Modified Davis classification — 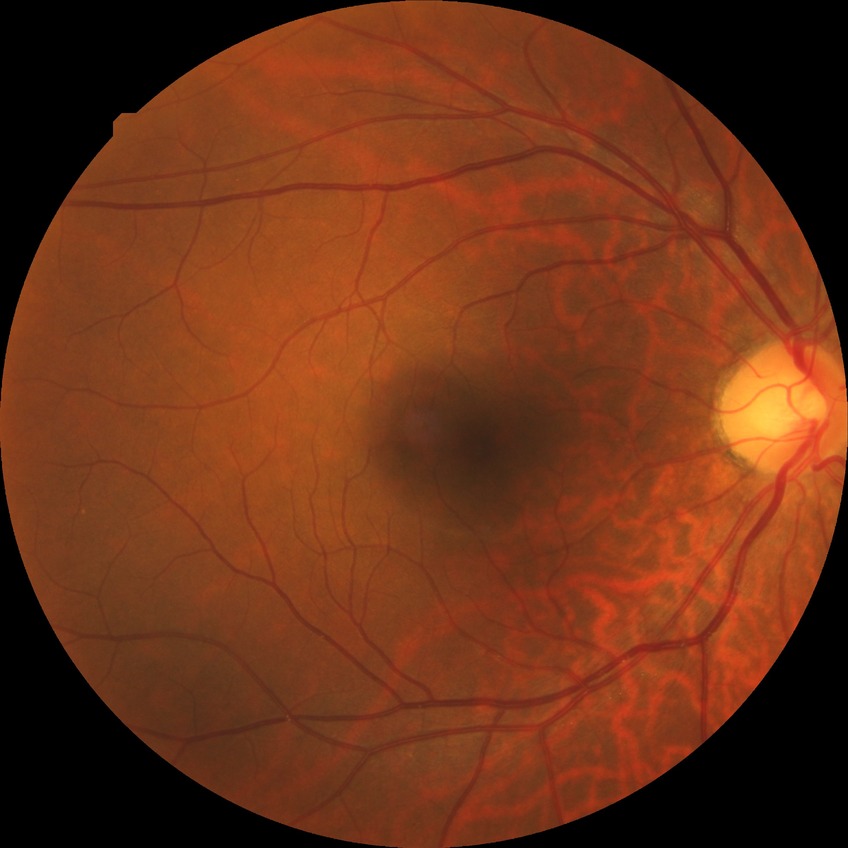

Modified Davis grade is NDR. No apparent diabetic retinopathy.